1932x1910; 45-degree field of view; color fundus image:
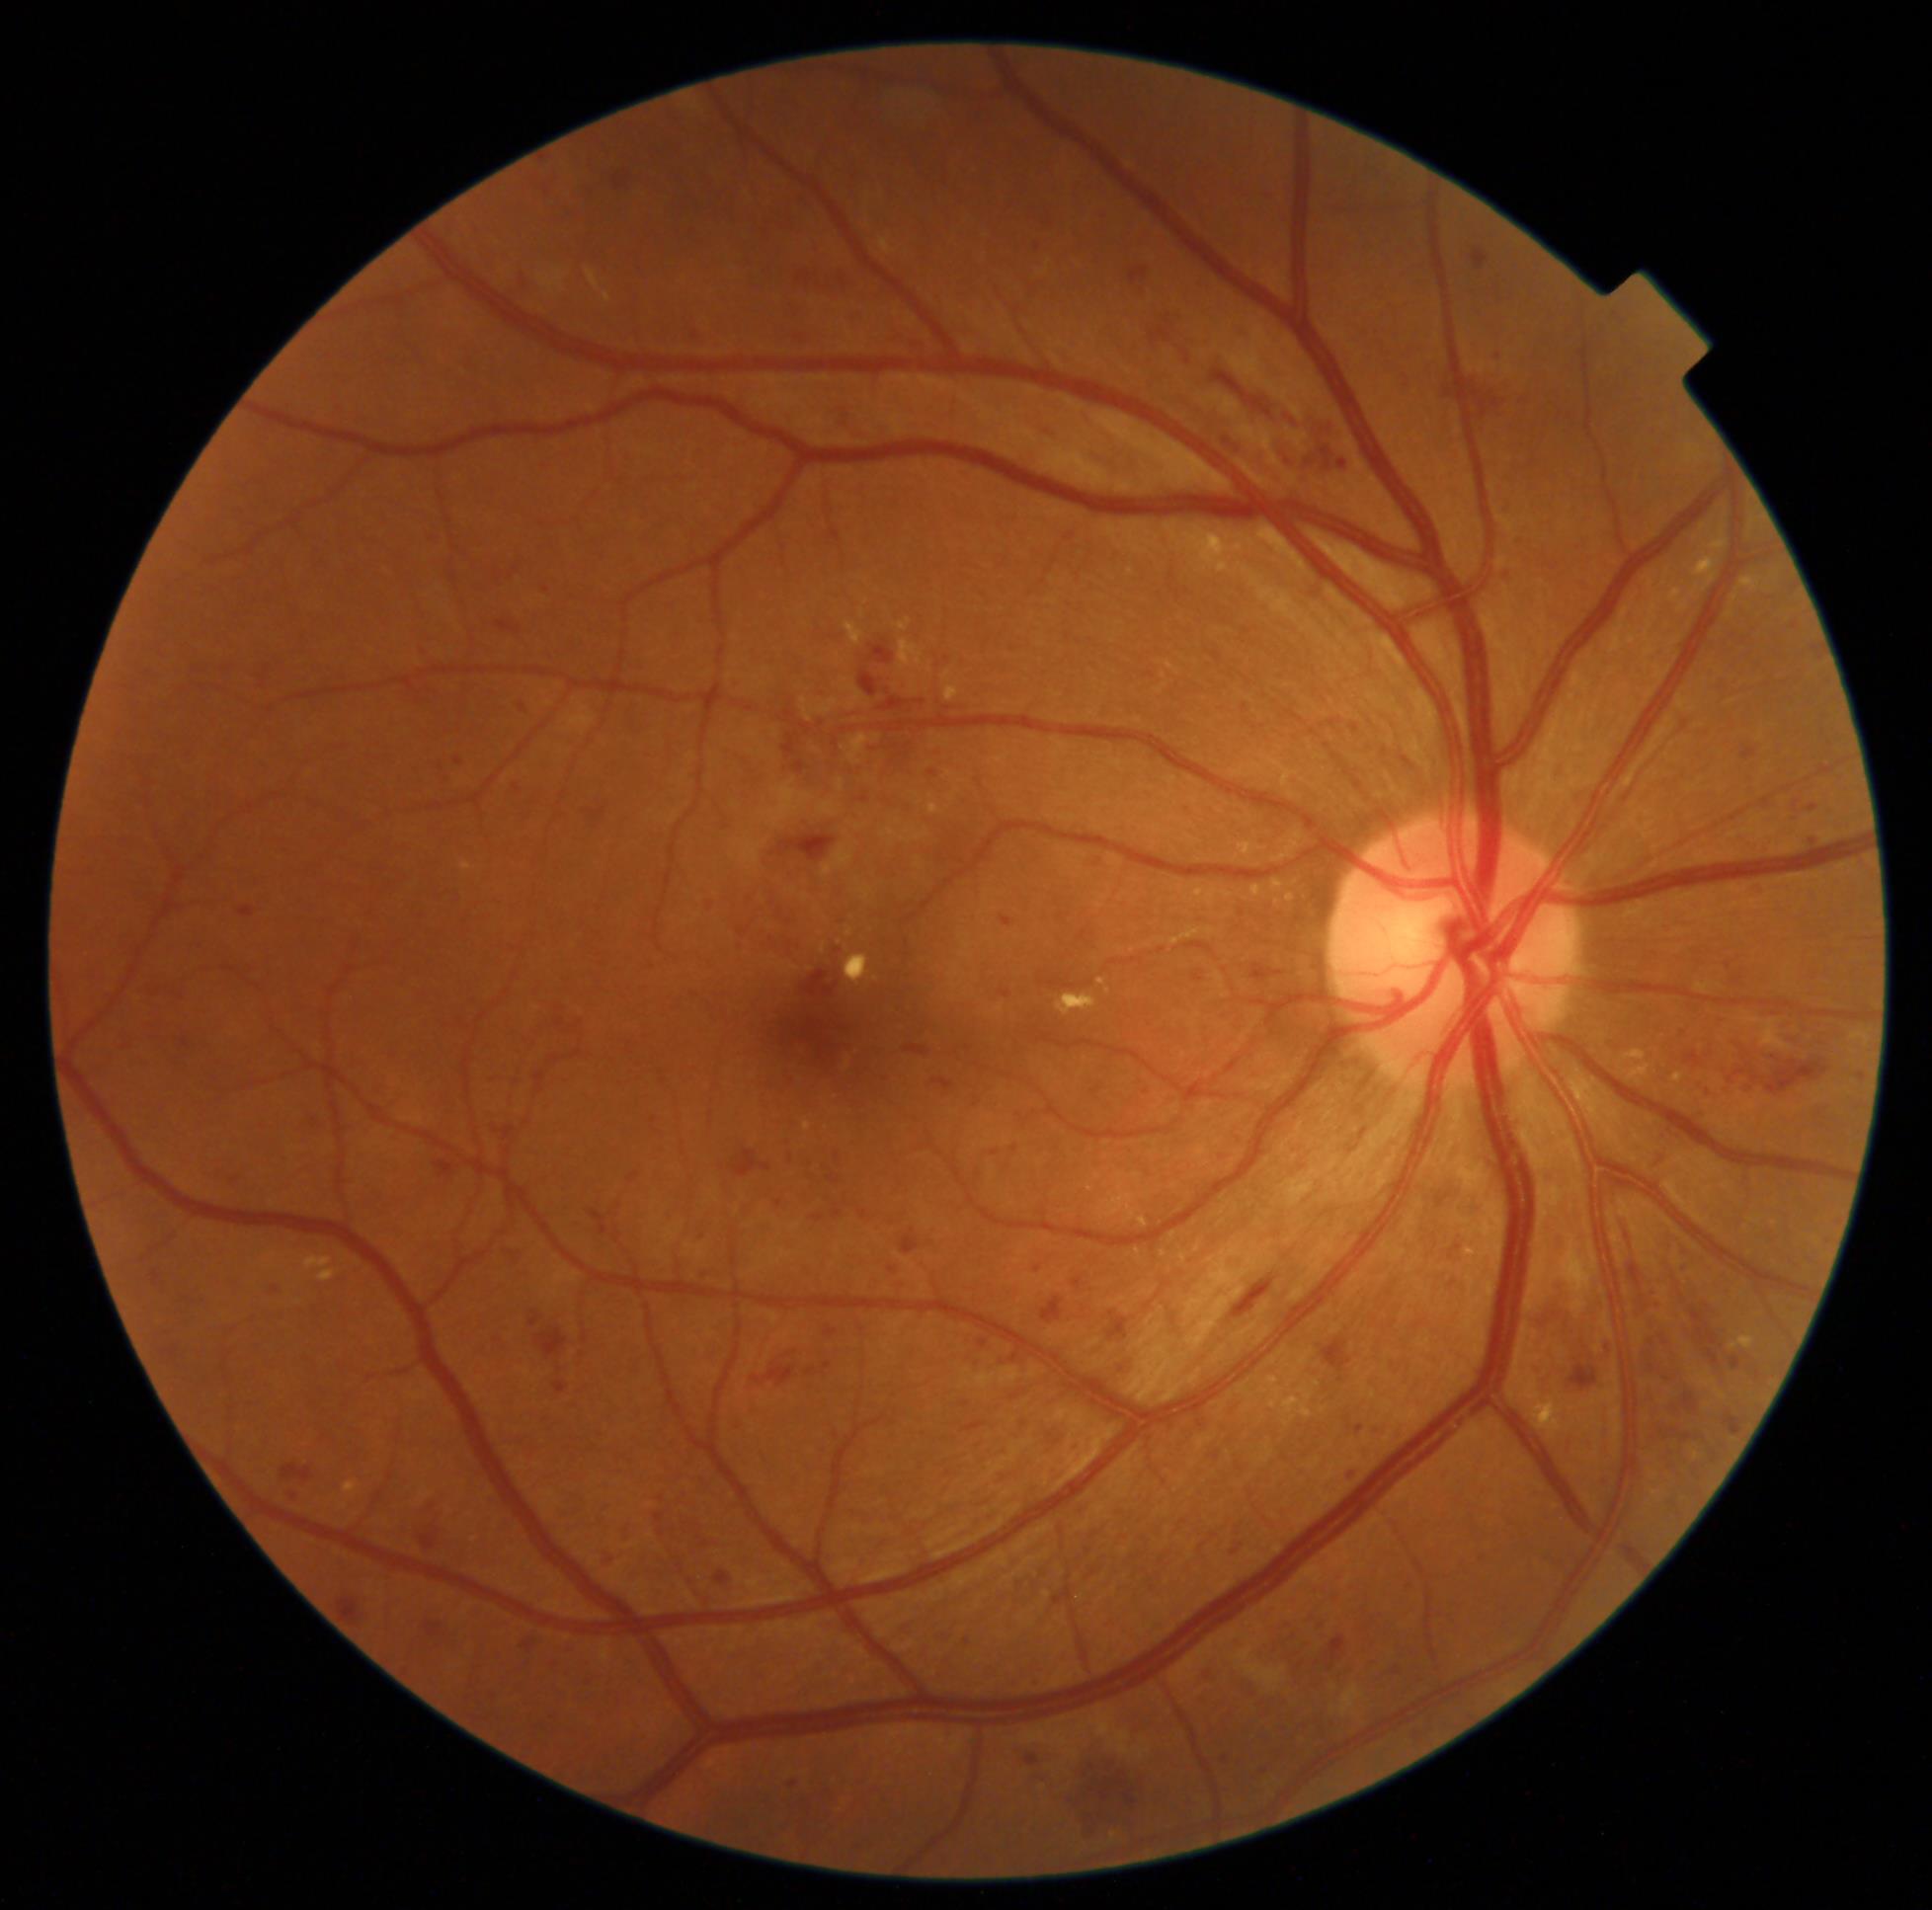 DR: grade 3 (severe NPDR).